Fundus photo — 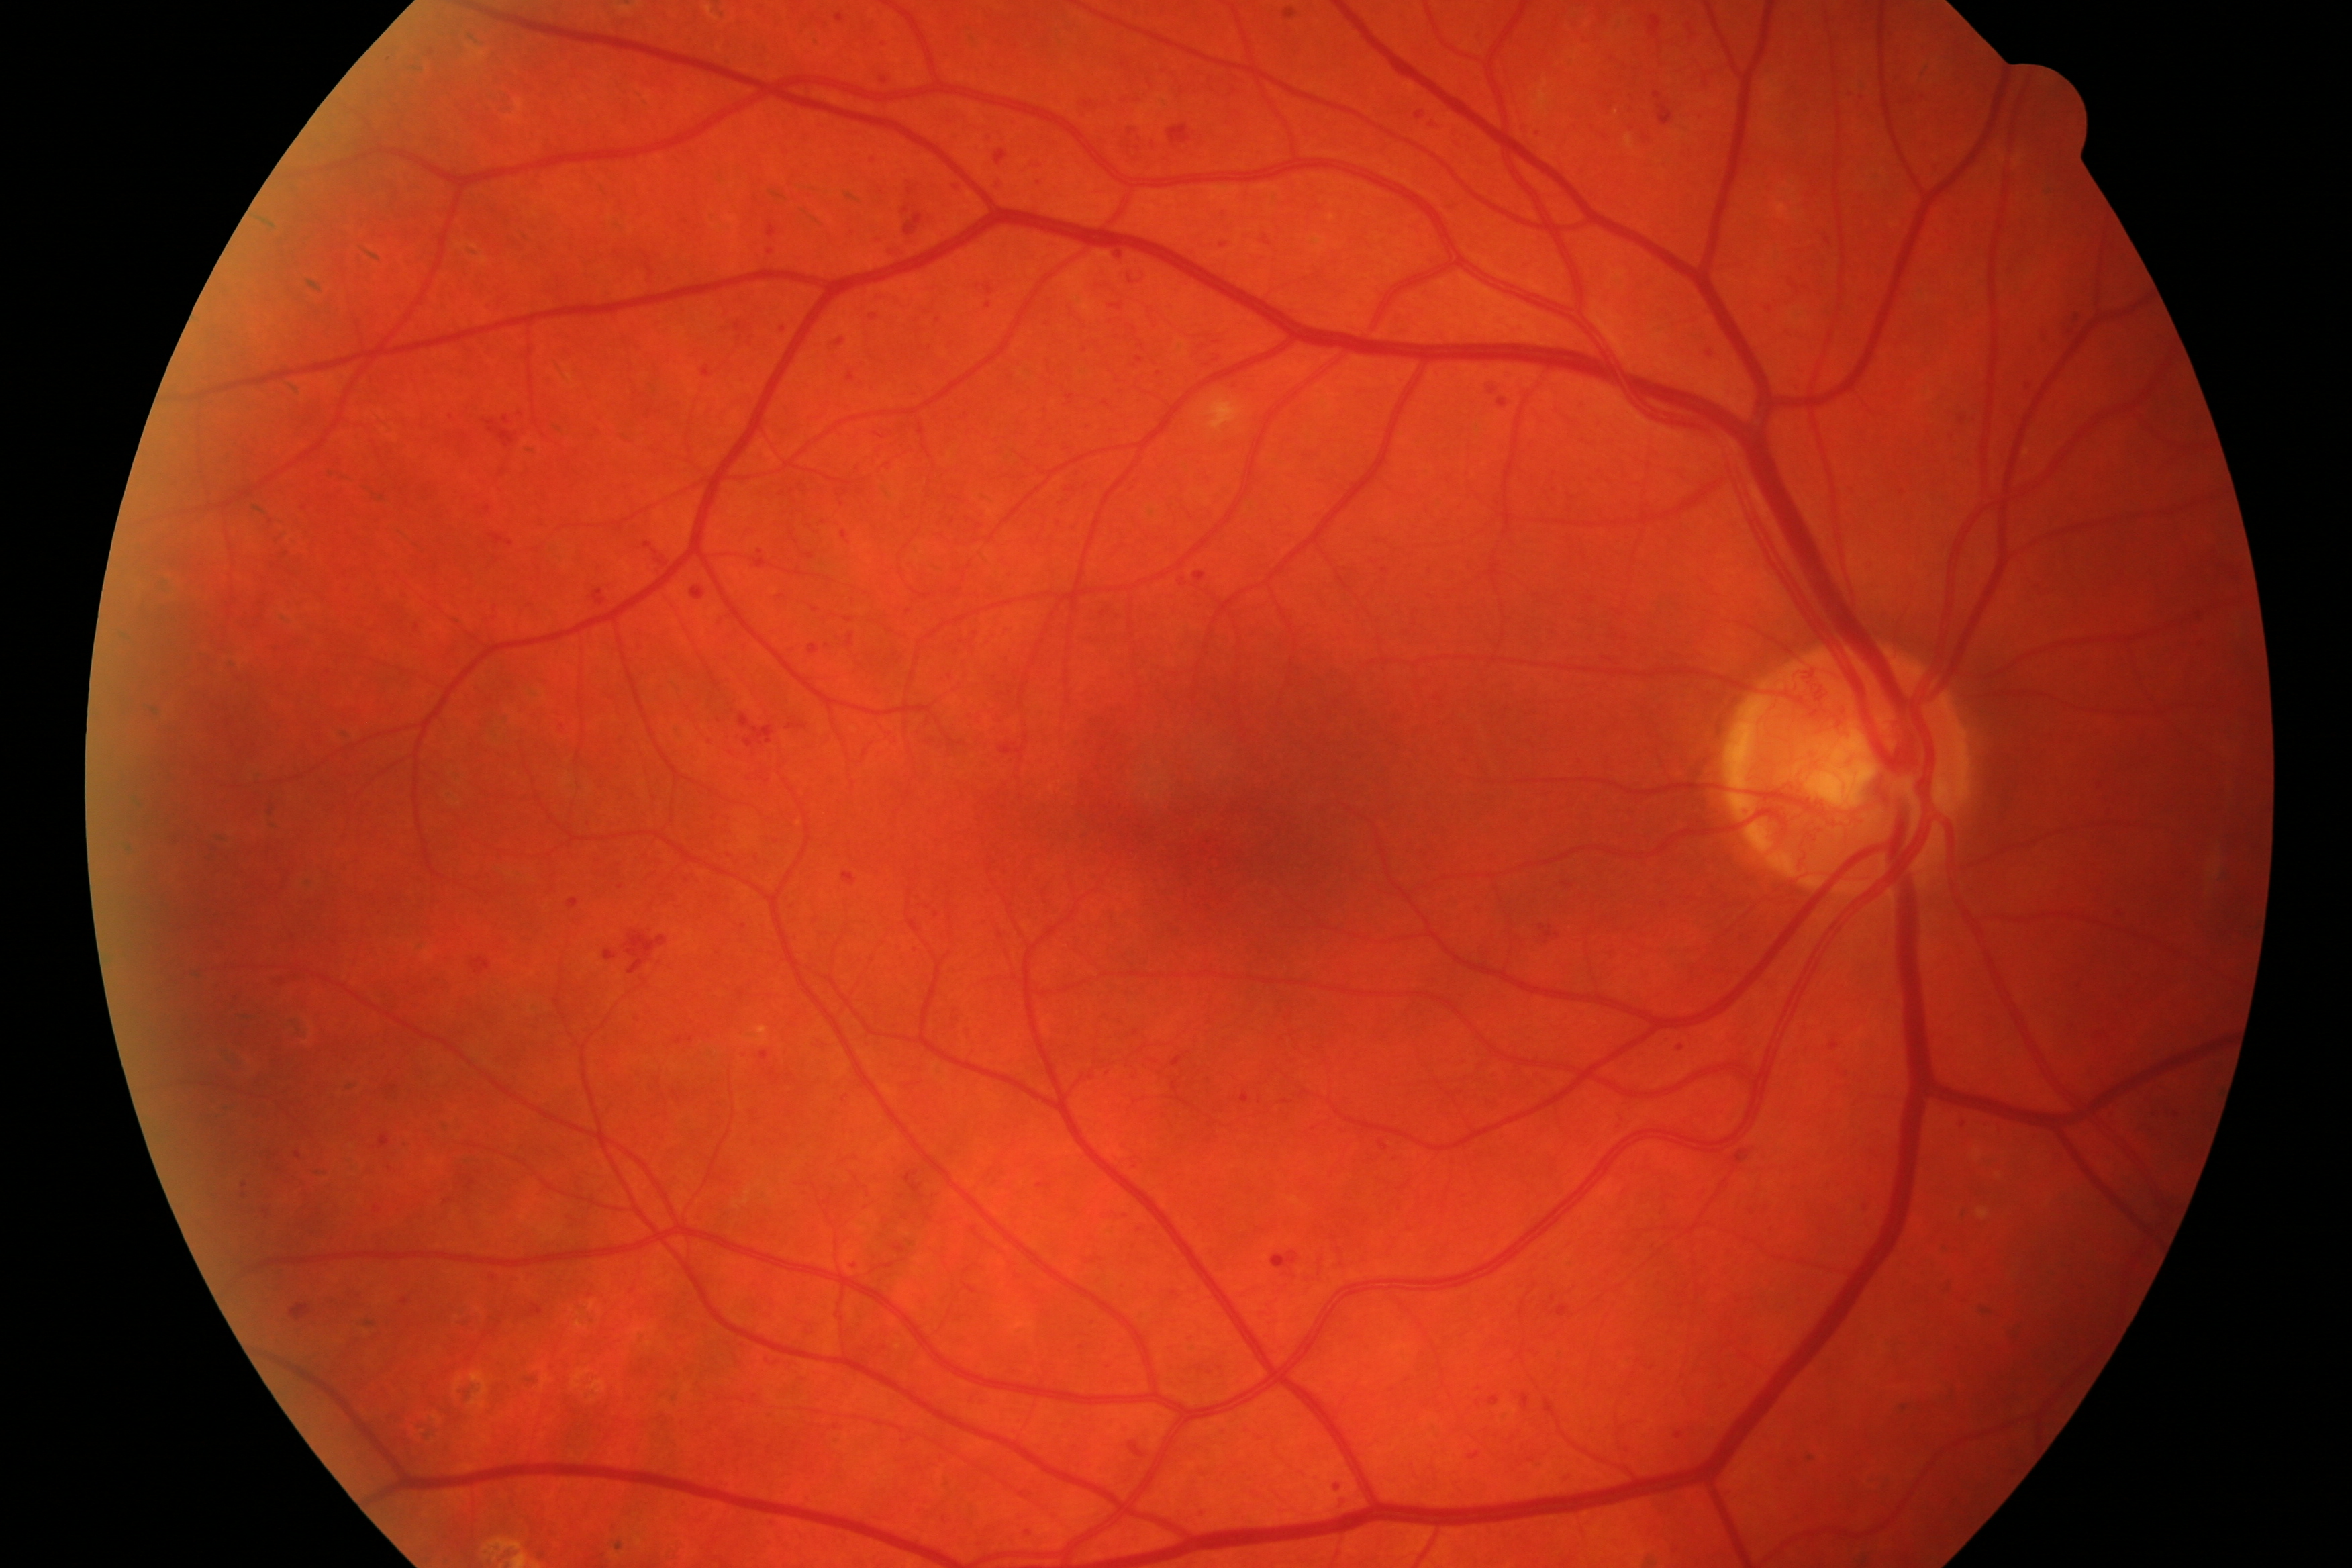

The image shows diabetic retinopathy.